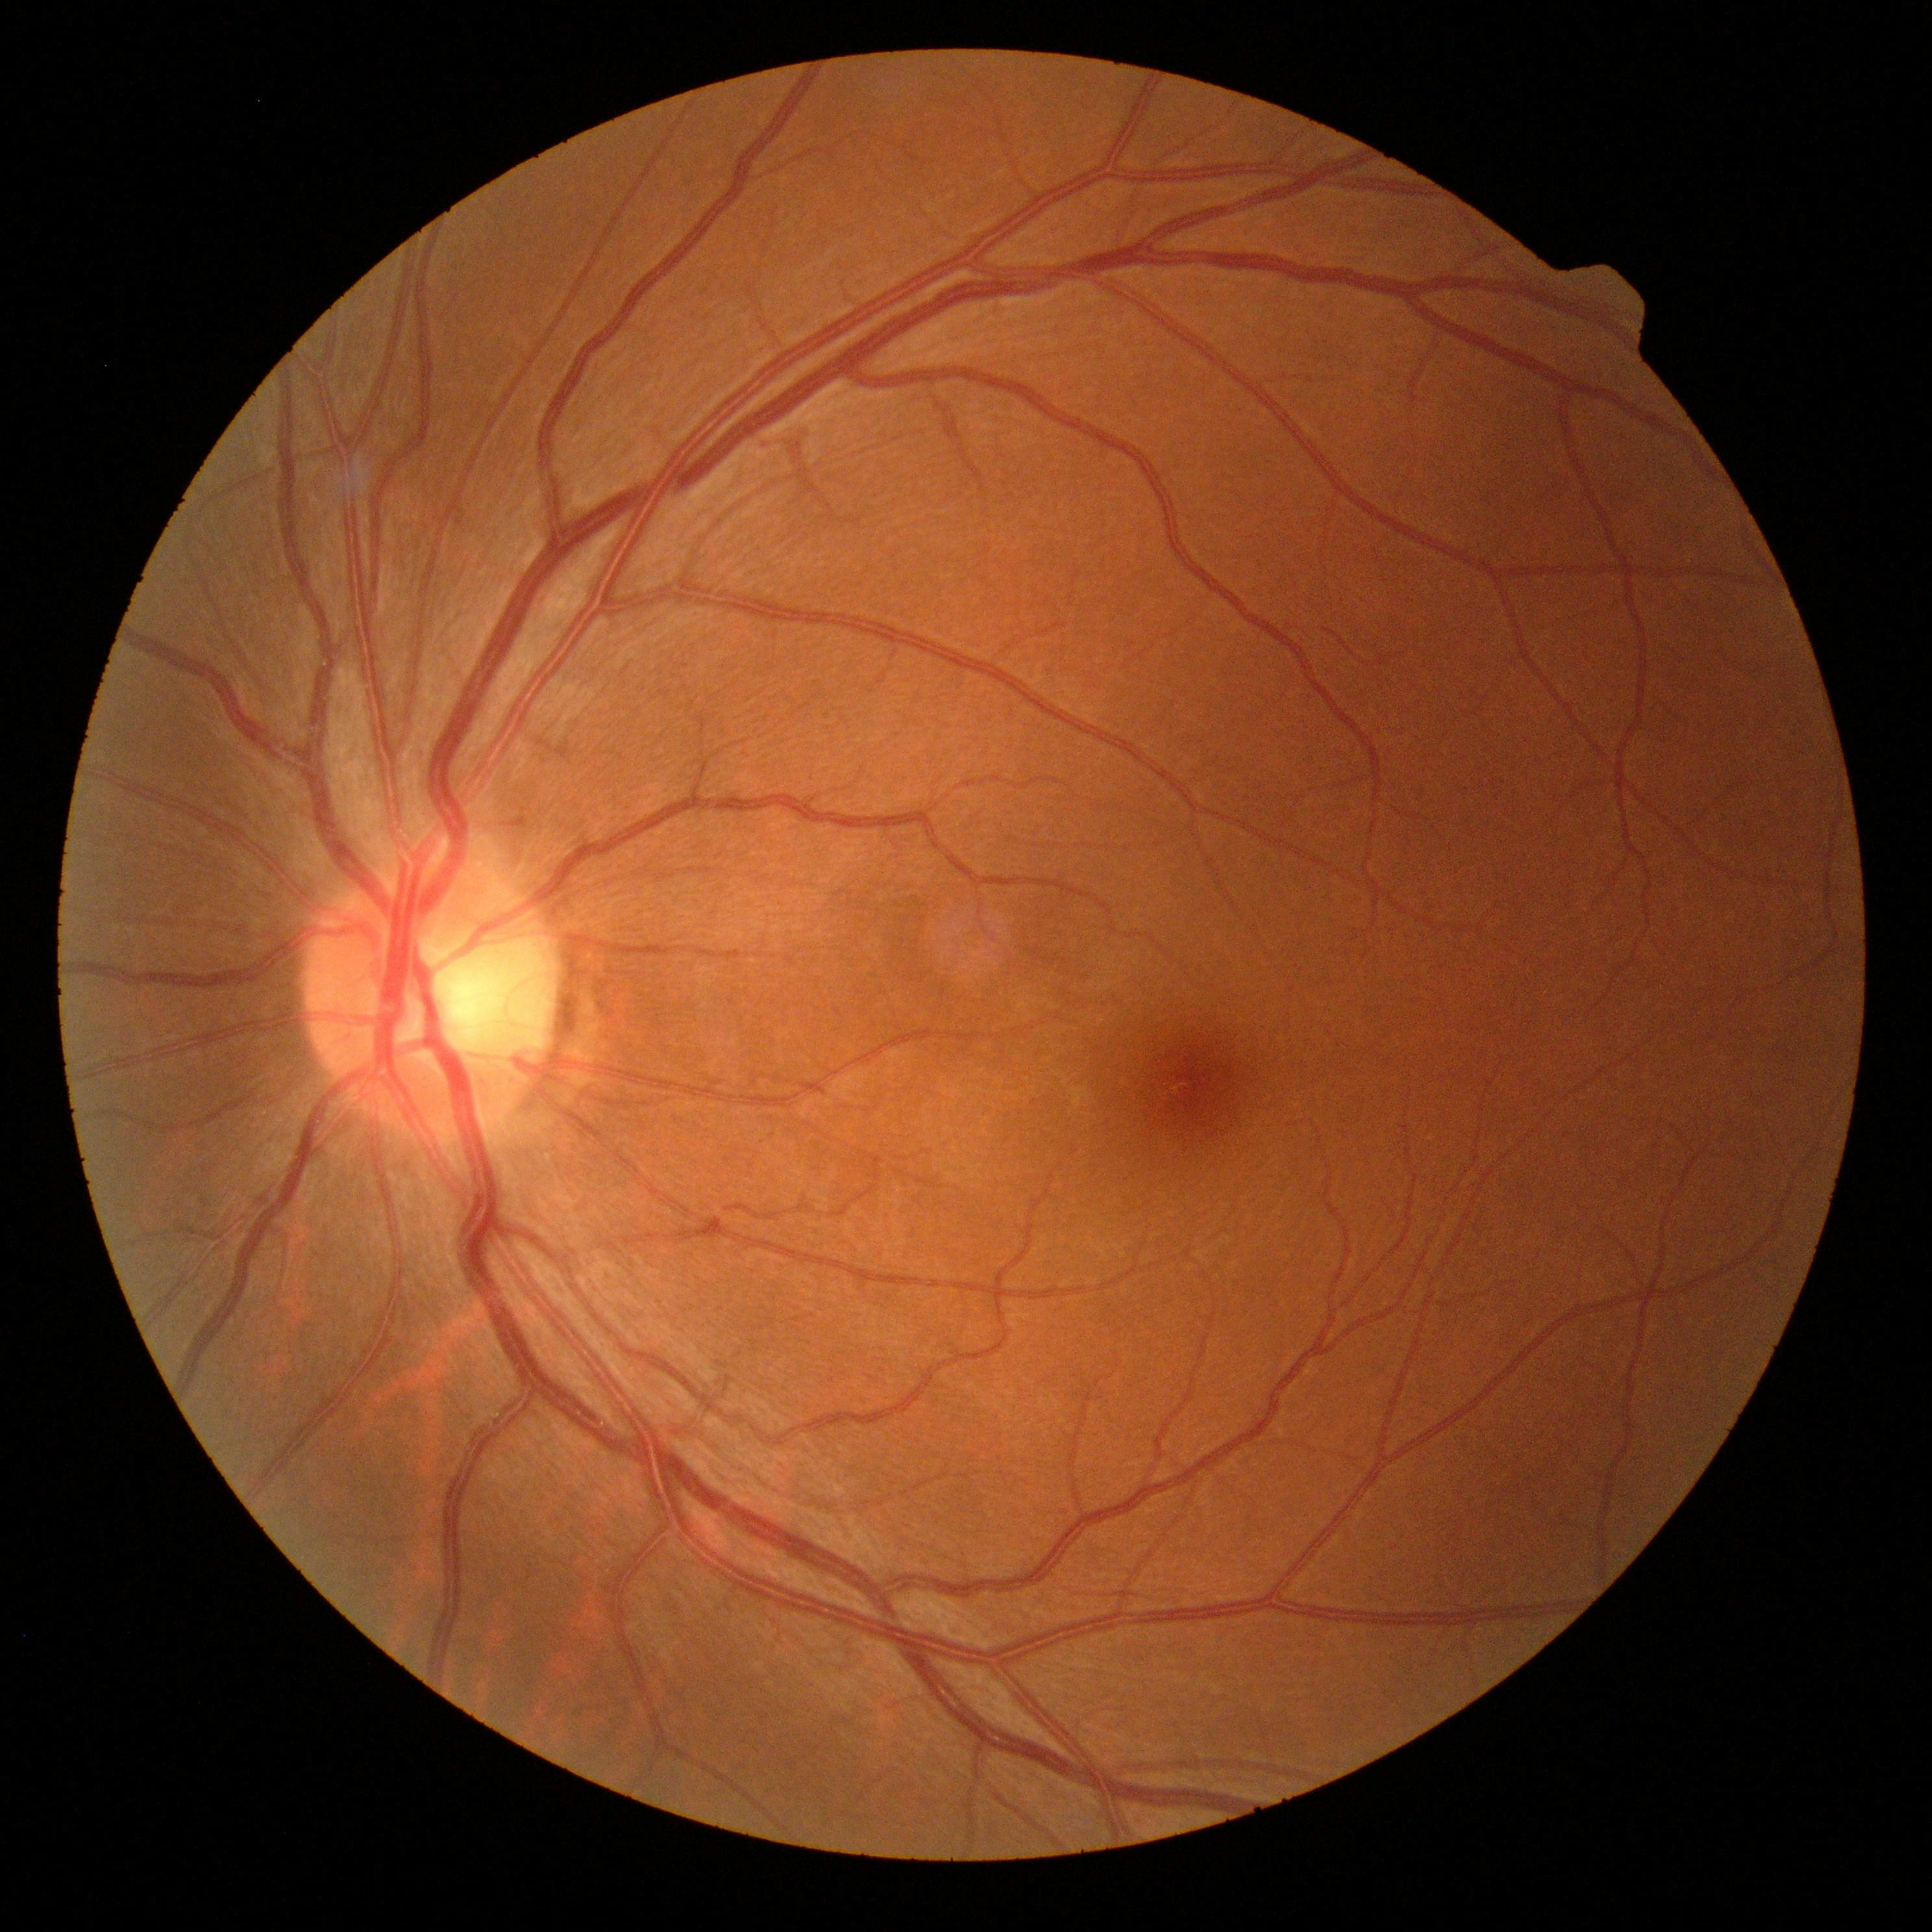

{"dr_impression": "no signs of DR", "dr_grade": "no apparent retinopathy (0) — no visible signs of diabetic retinopathy"}